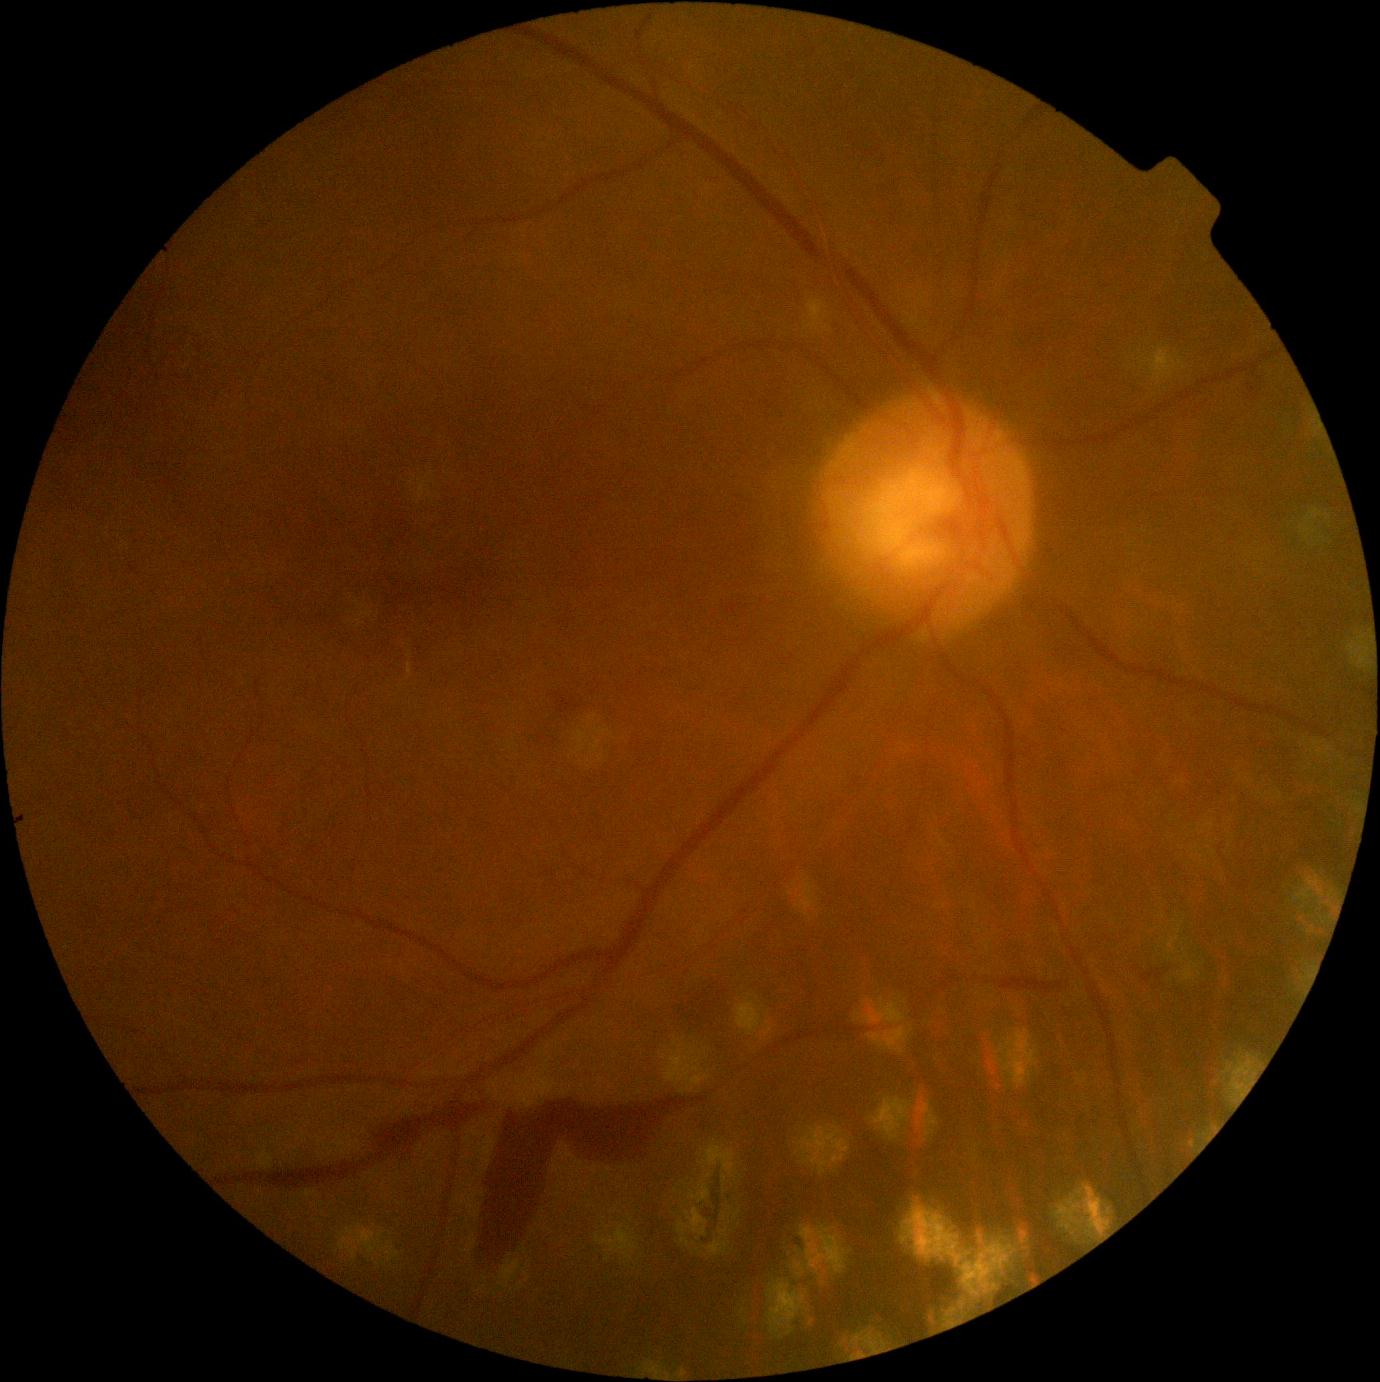

{
  "dr_grade": "PDR (grade 4)"
}